Captured with the Clarity RetCam 3 (130° field of view); pediatric retinal photograph (wide-field):
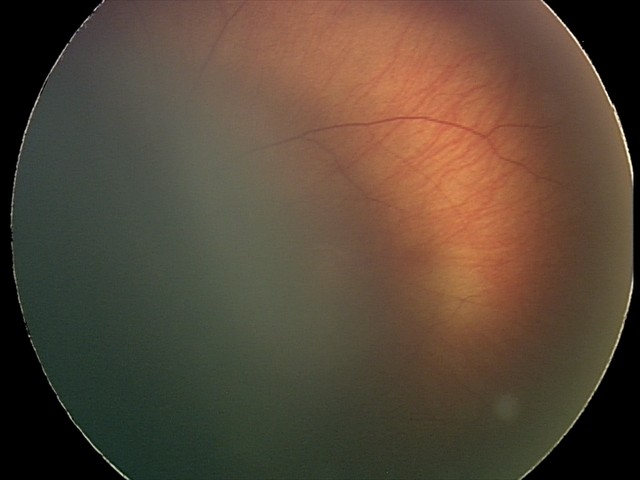 Assessment: retinal hemorrhages.